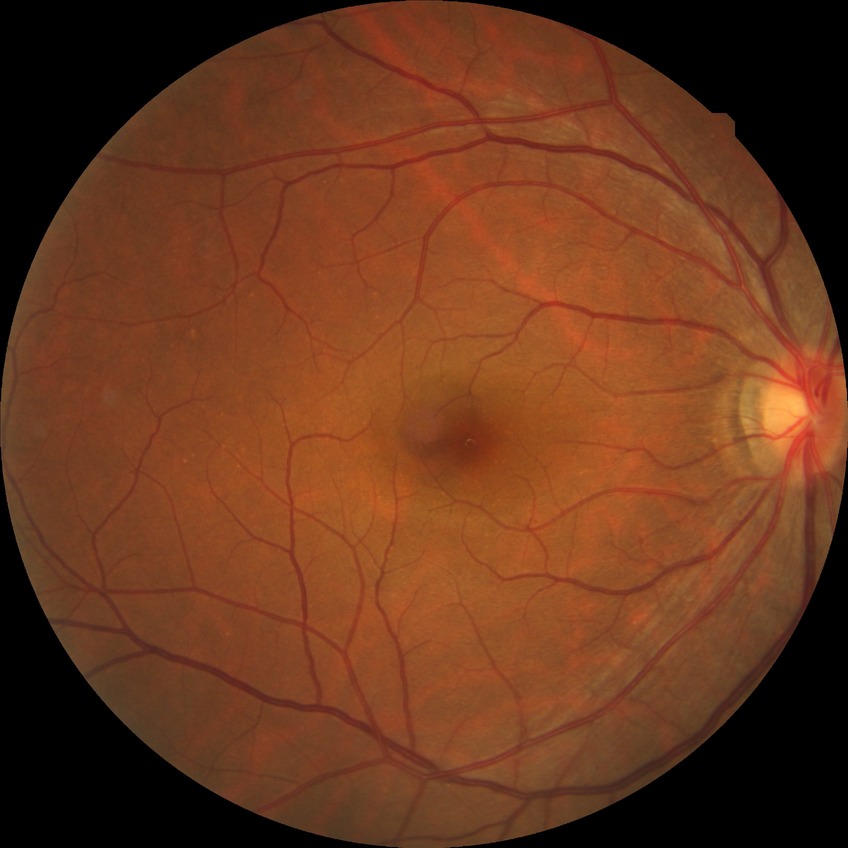
Diabetic retinopathy (DR) is NDR (no diabetic retinopathy).